Camera: Phoenix ICON (100° FOV) · wide-field fundus photograph from neonatal ROP screening · 1240x1240px: 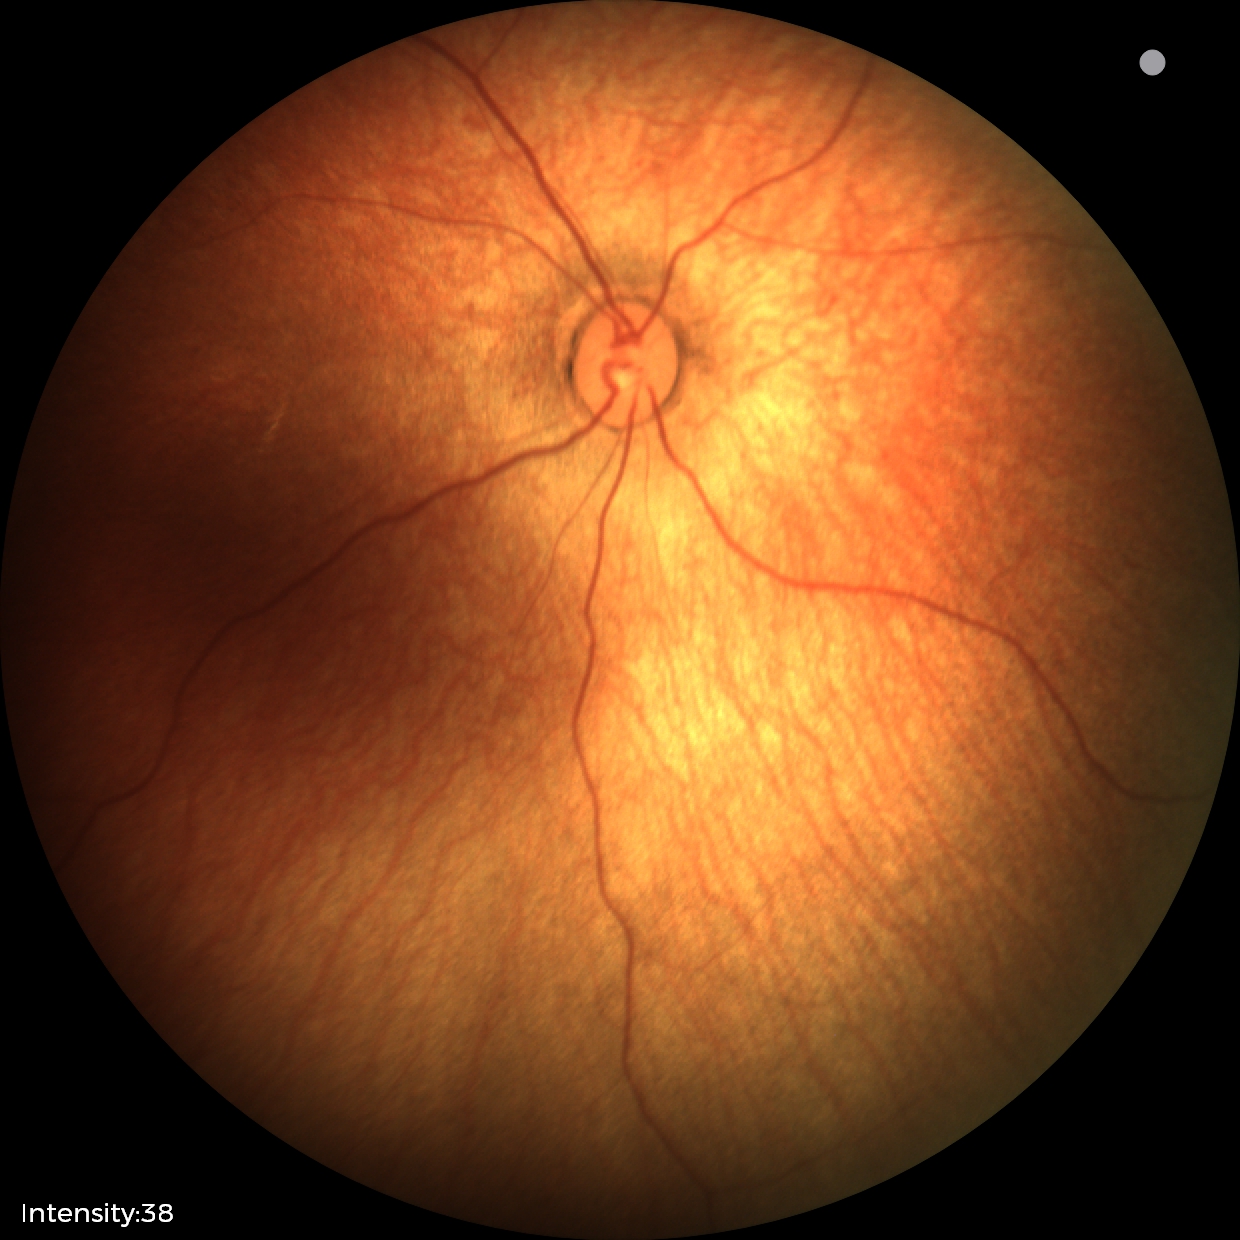
Normal screening examination.